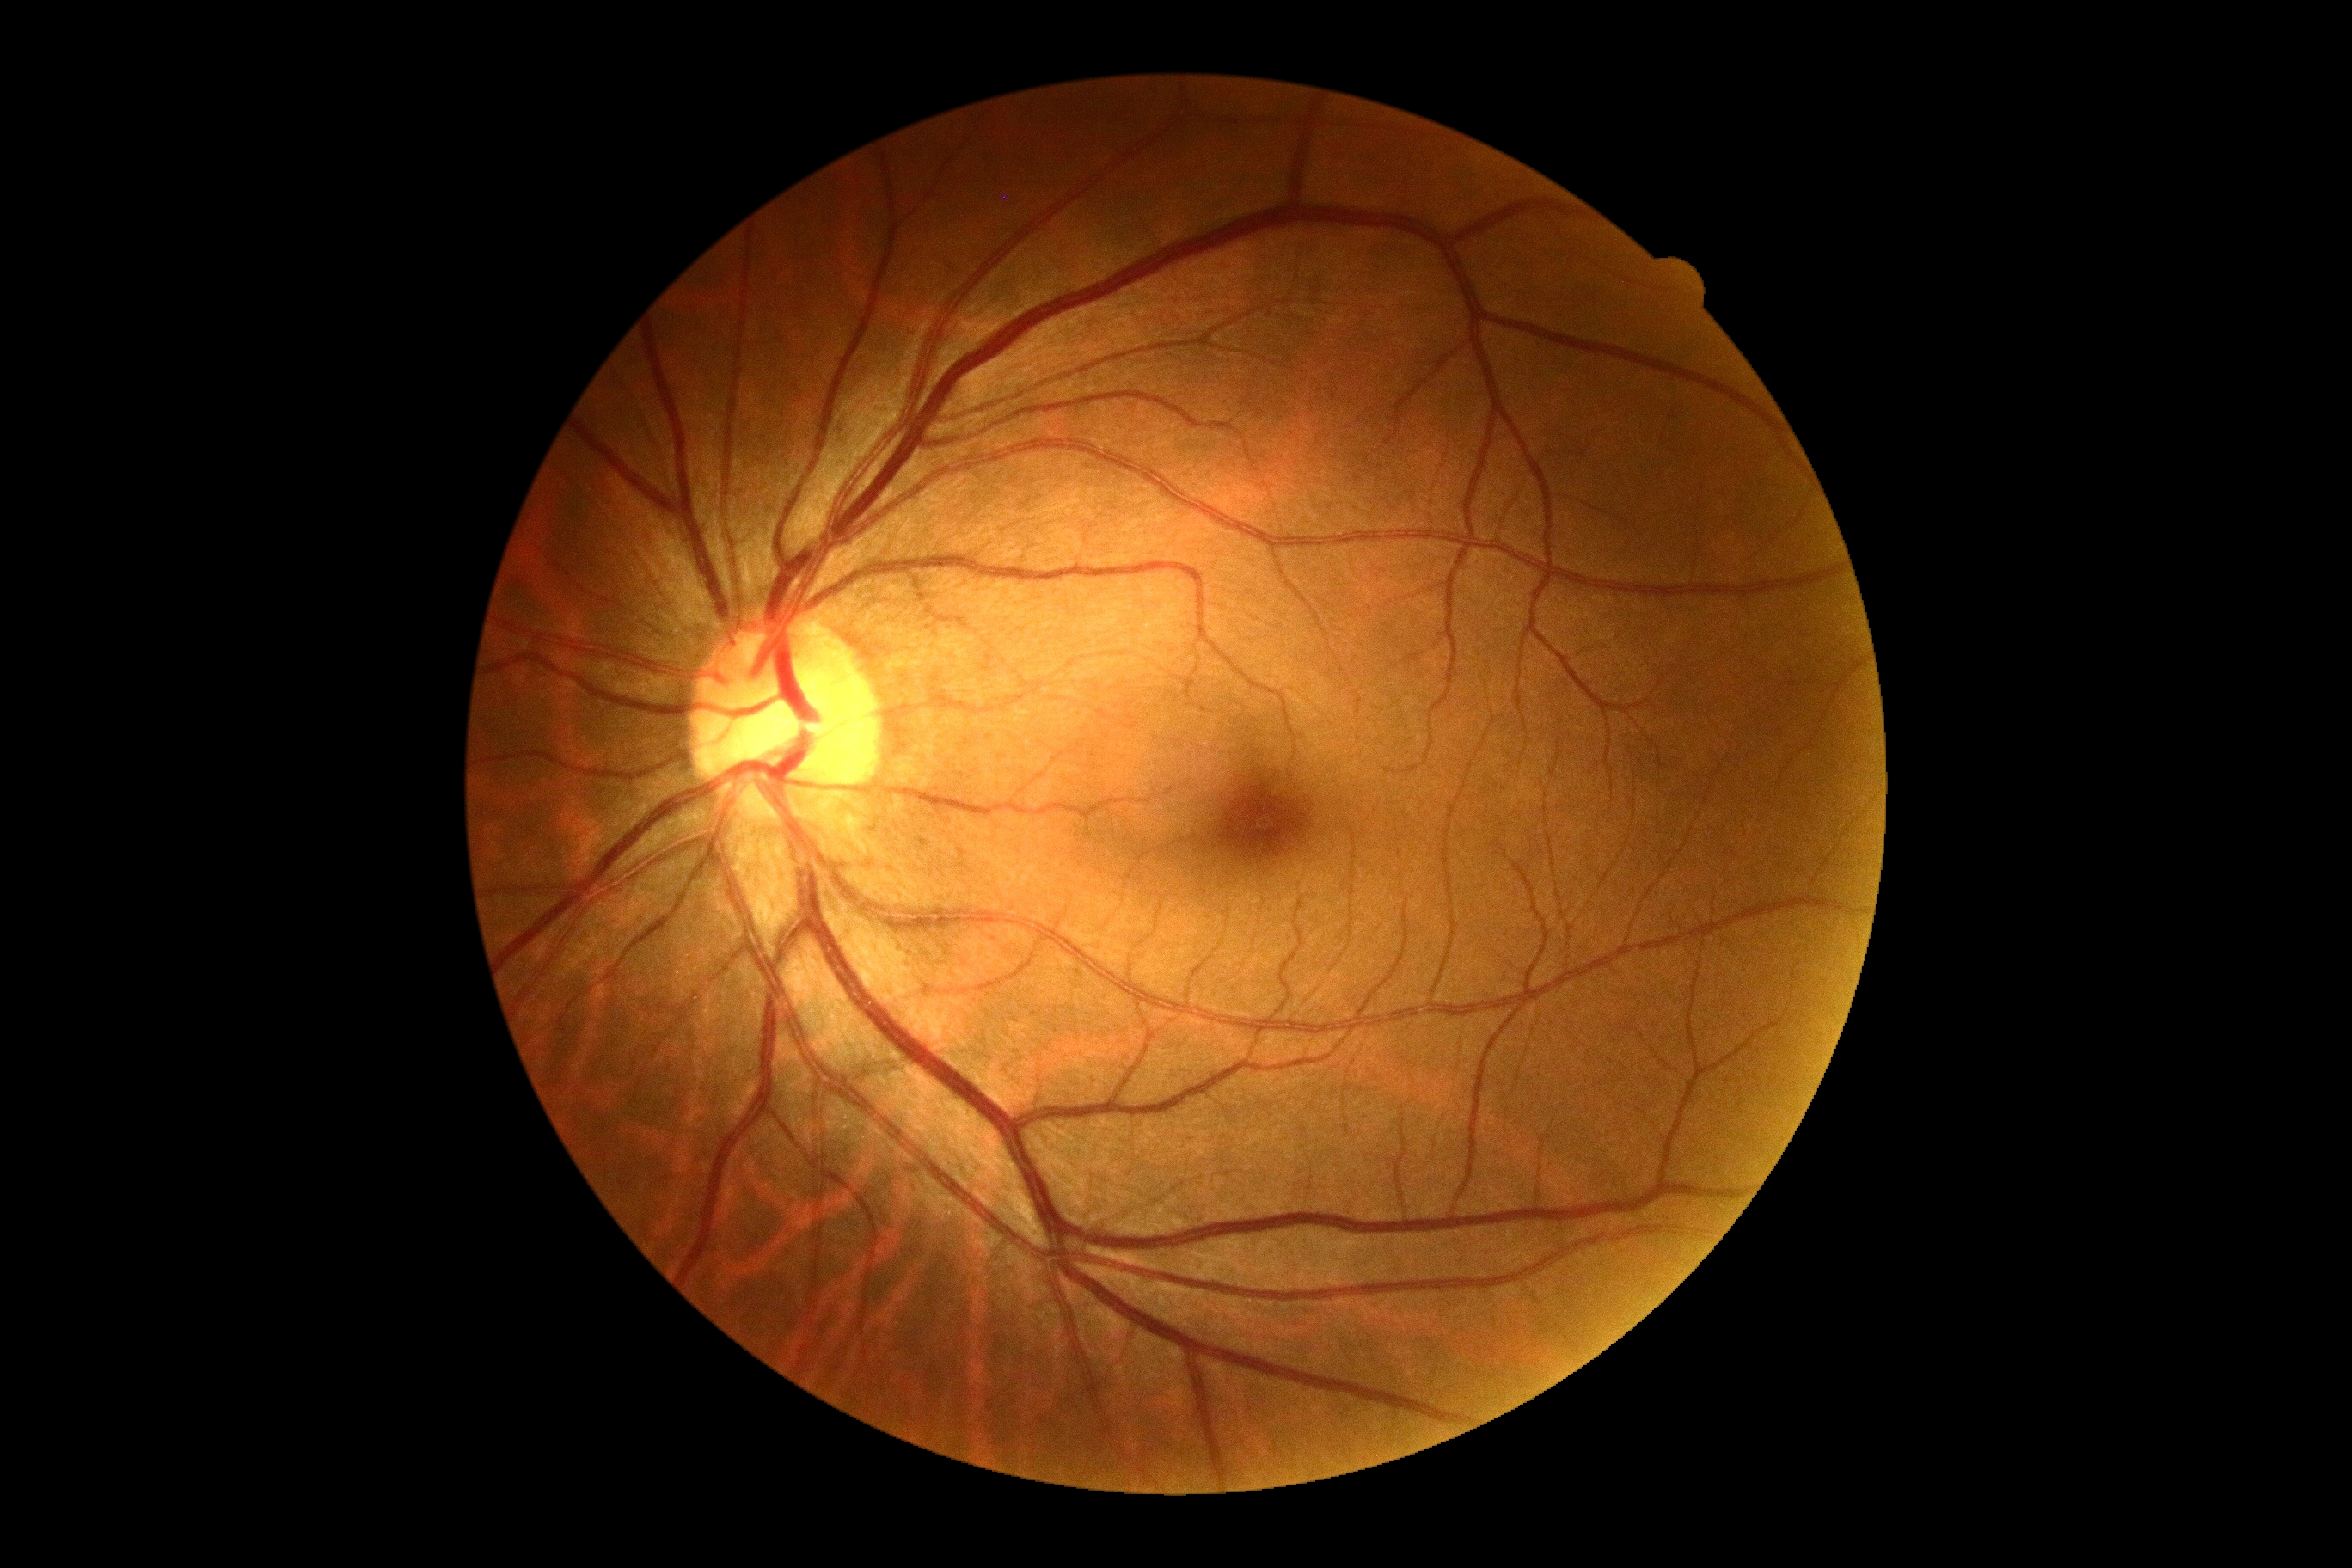 {"dr_grade": "no apparent retinopathy (grade 0)"}